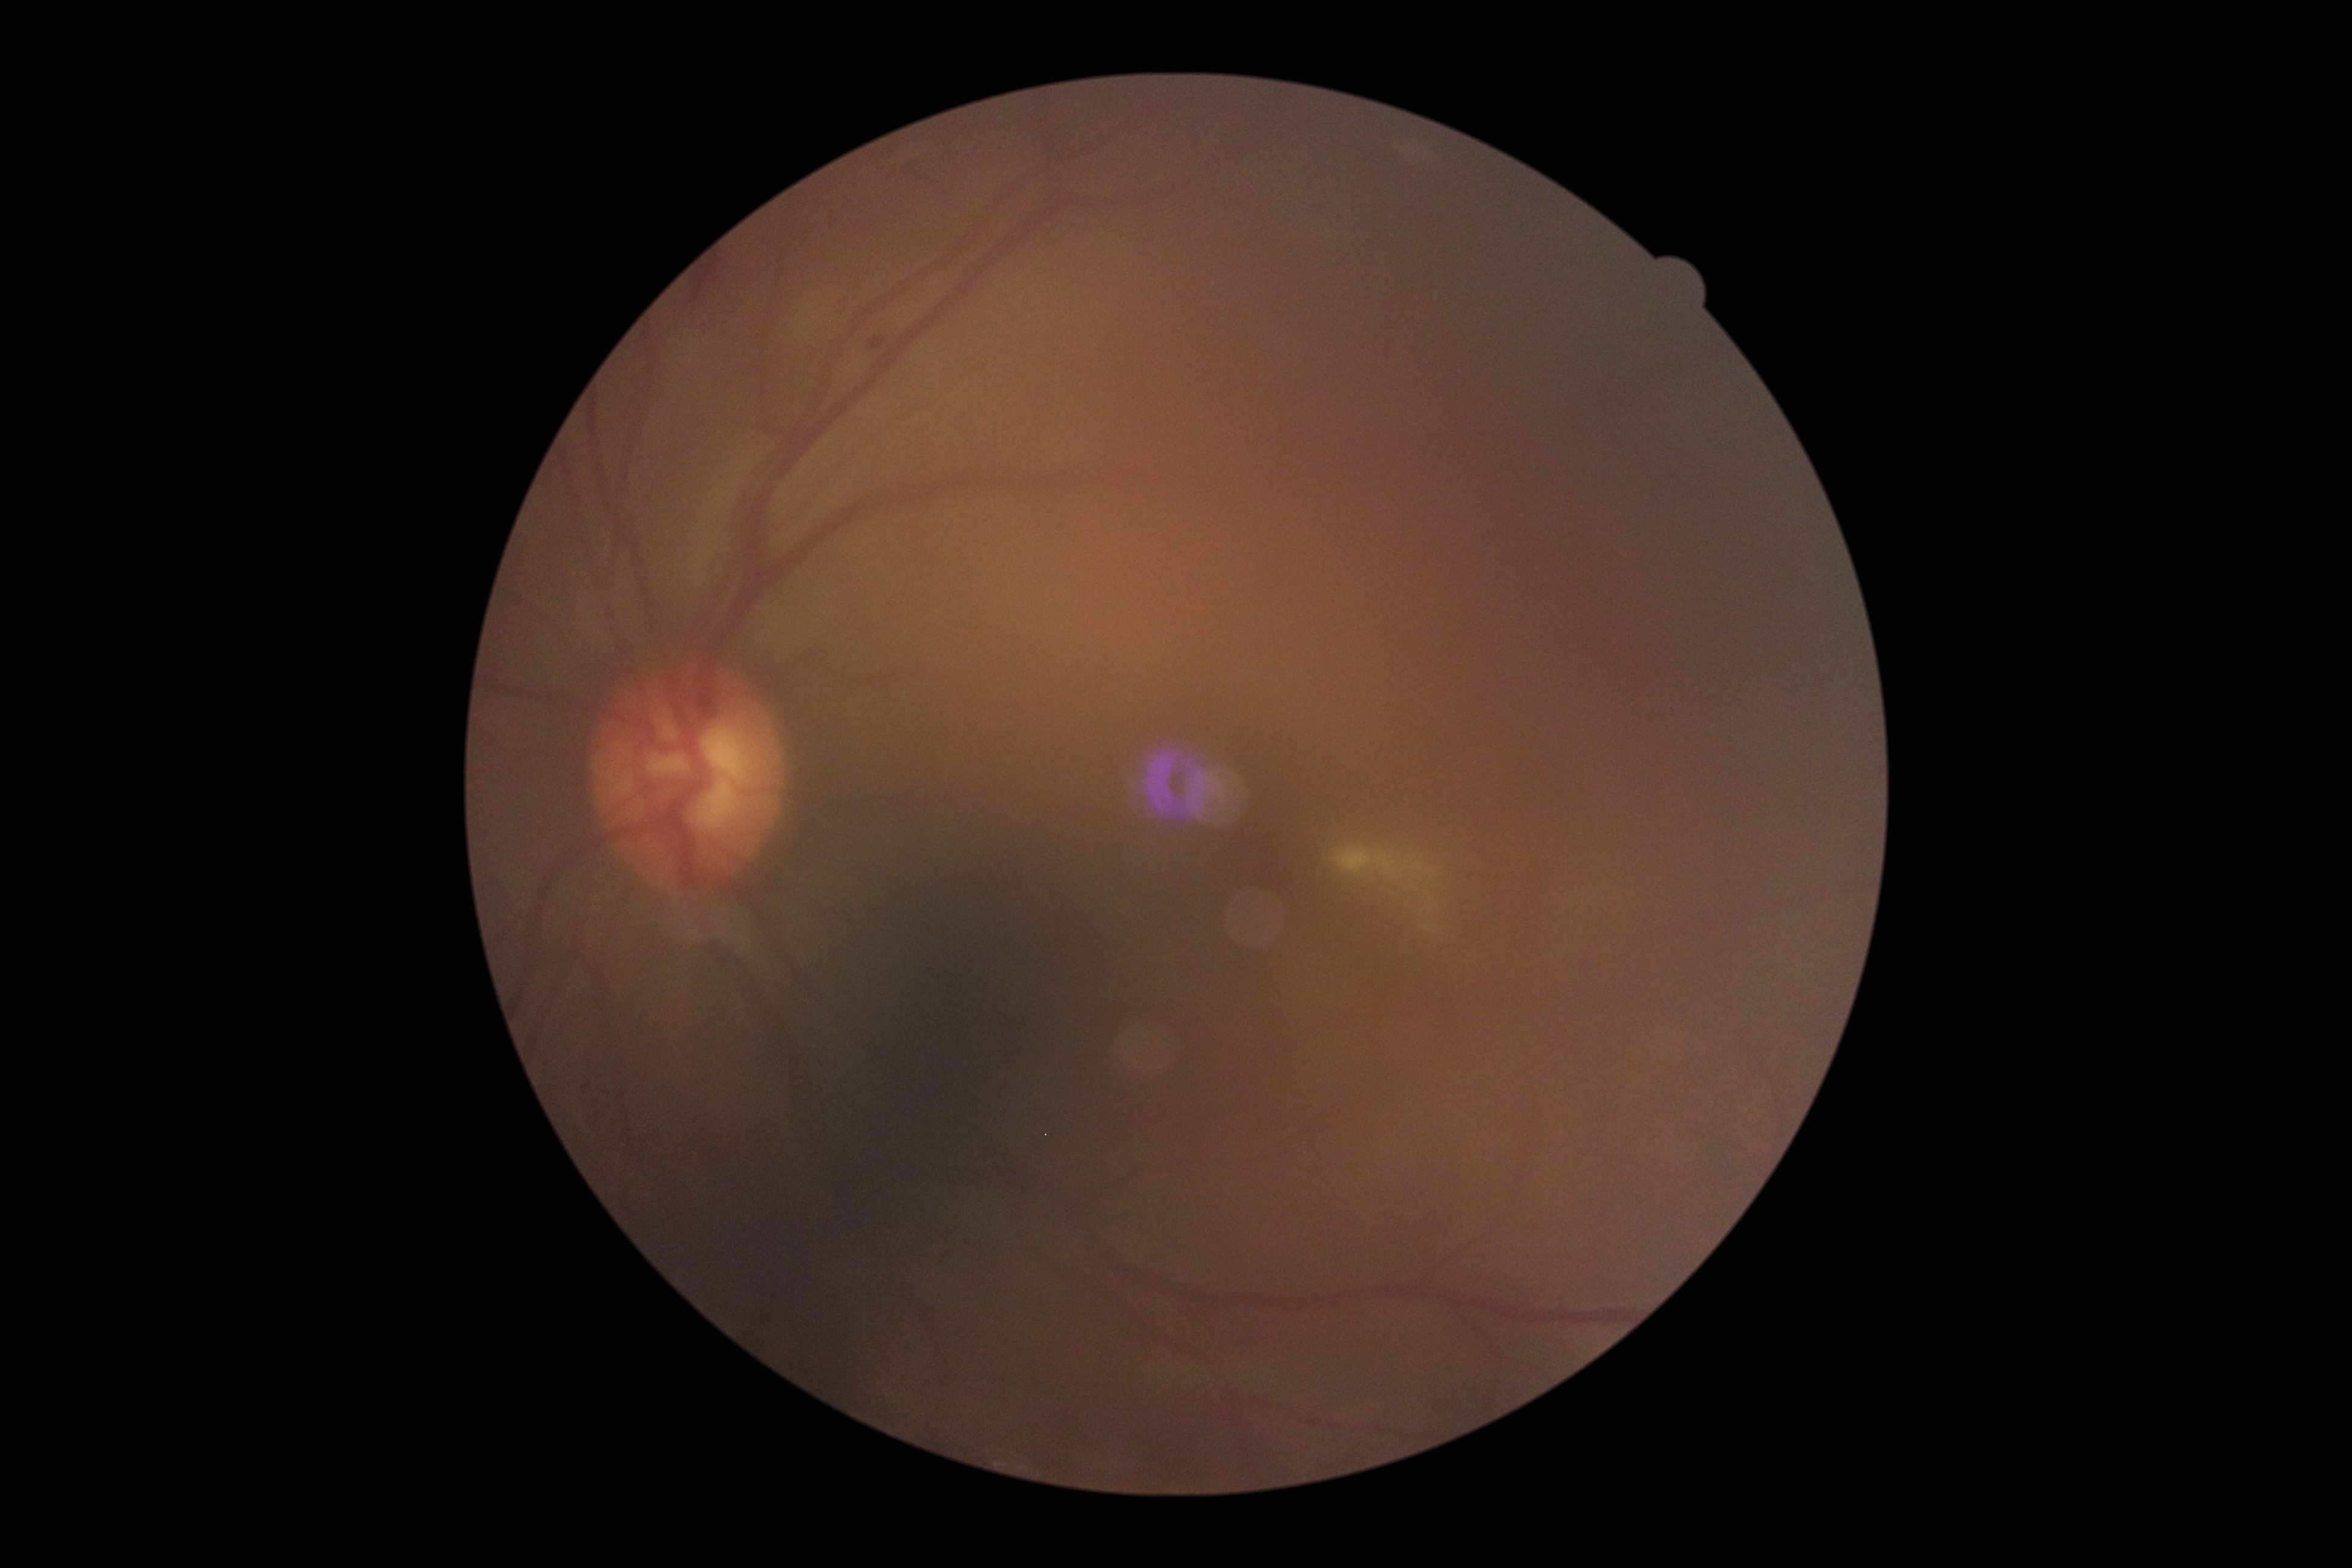
DR: grade 2.